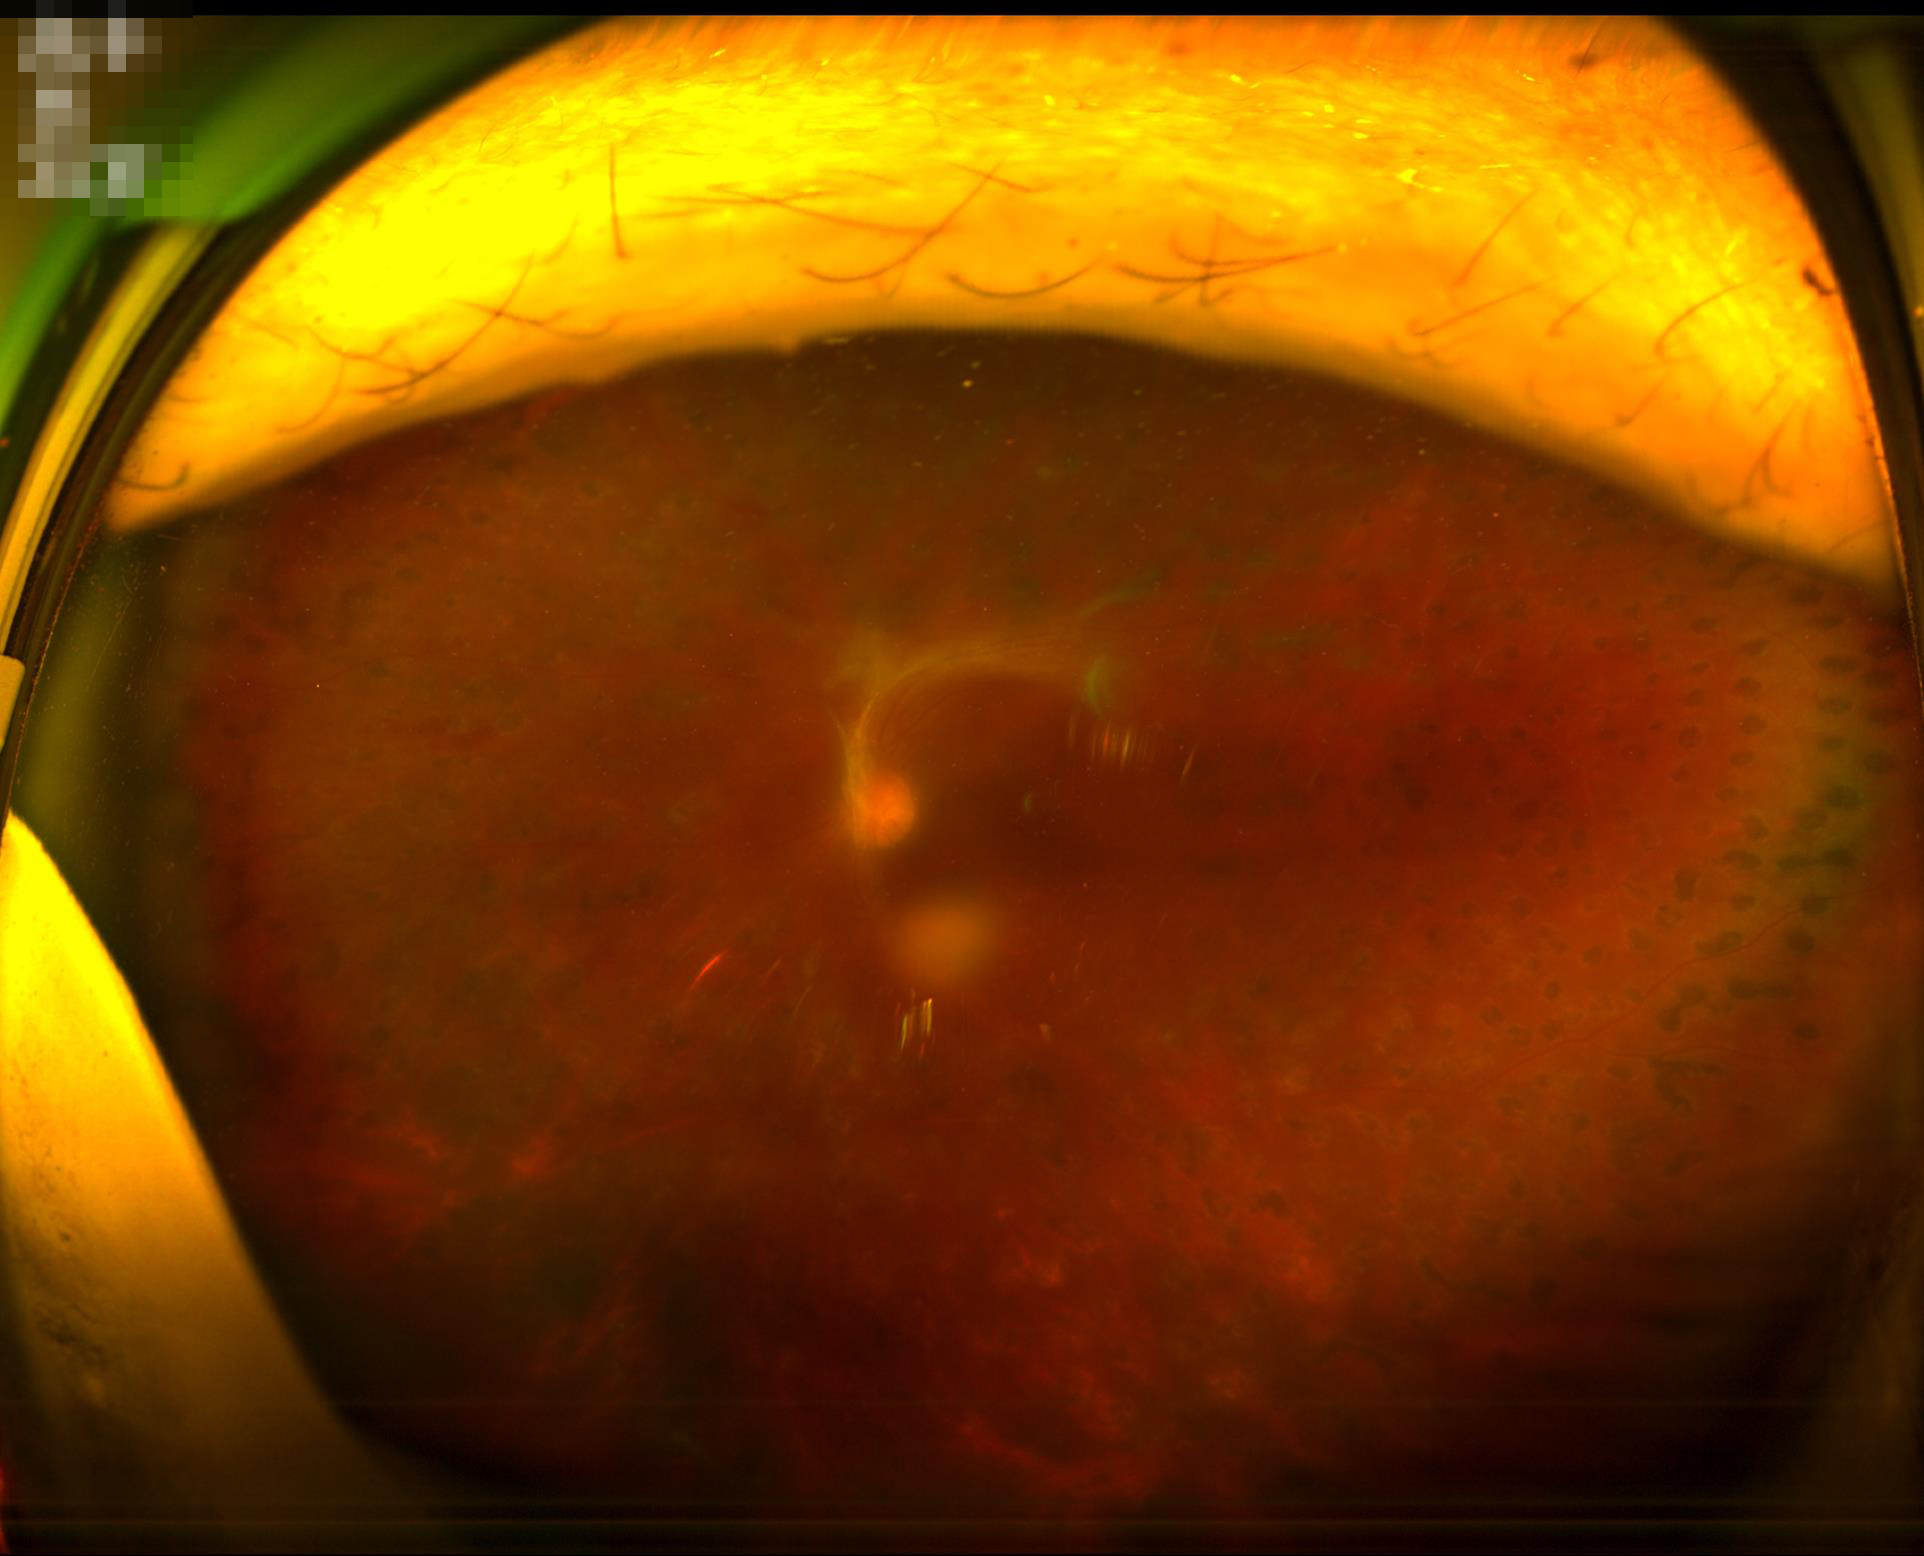
Image quality:
- contrast: poor
- clarity: out of focus
- overall: low
- illumination/color: suboptimal